NIDEK AFC-230, 45° FOV, 848 x 848 pixels, DR severity per modified Davis staging
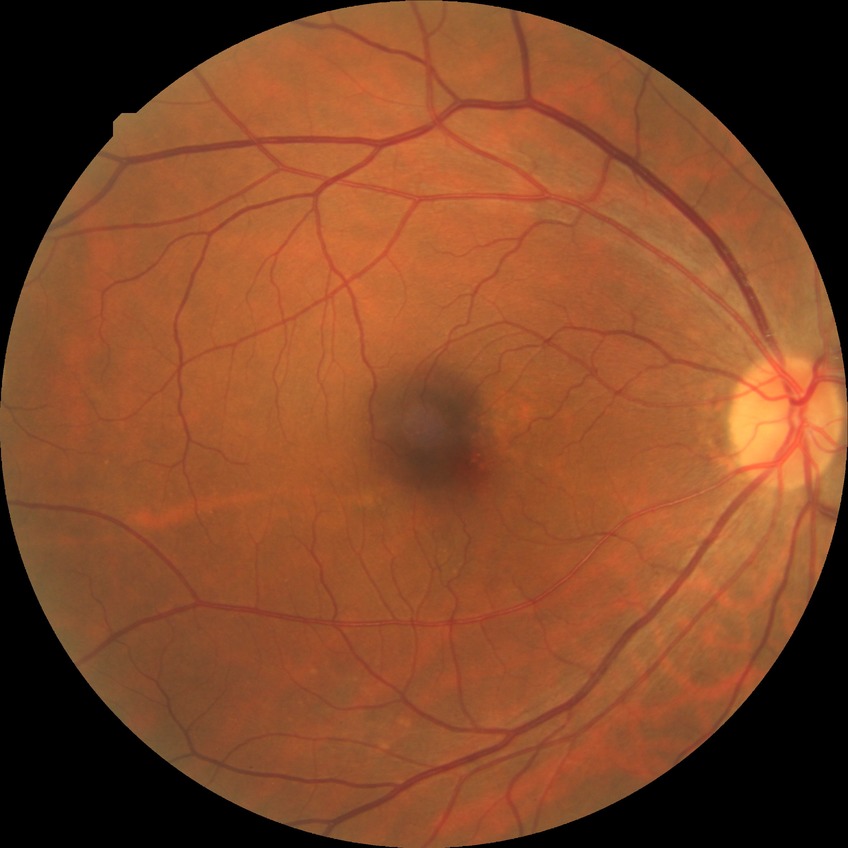
Diabetic retinopathy (DR) is NDR (no diabetic retinopathy).